FOV: 45 degrees:
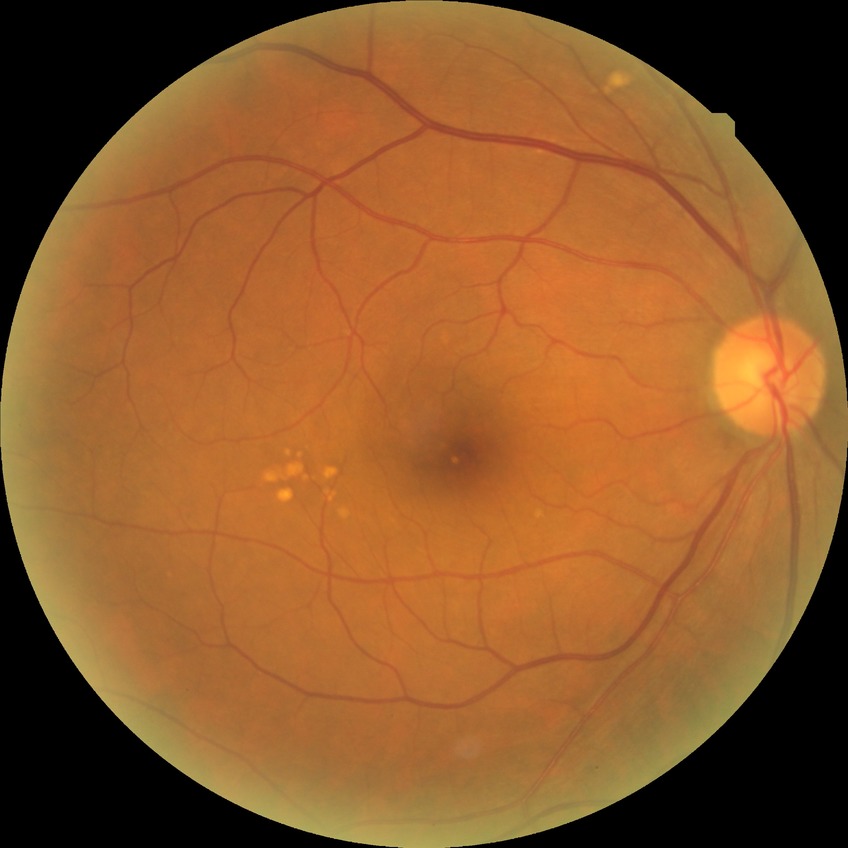

diabetic retinopathy (DR) = no diabetic retinopathy (NDR)